Color fundus photograph · captured on a Remidio Fundus on Phone (FOP) camera · image size 1659x2212:
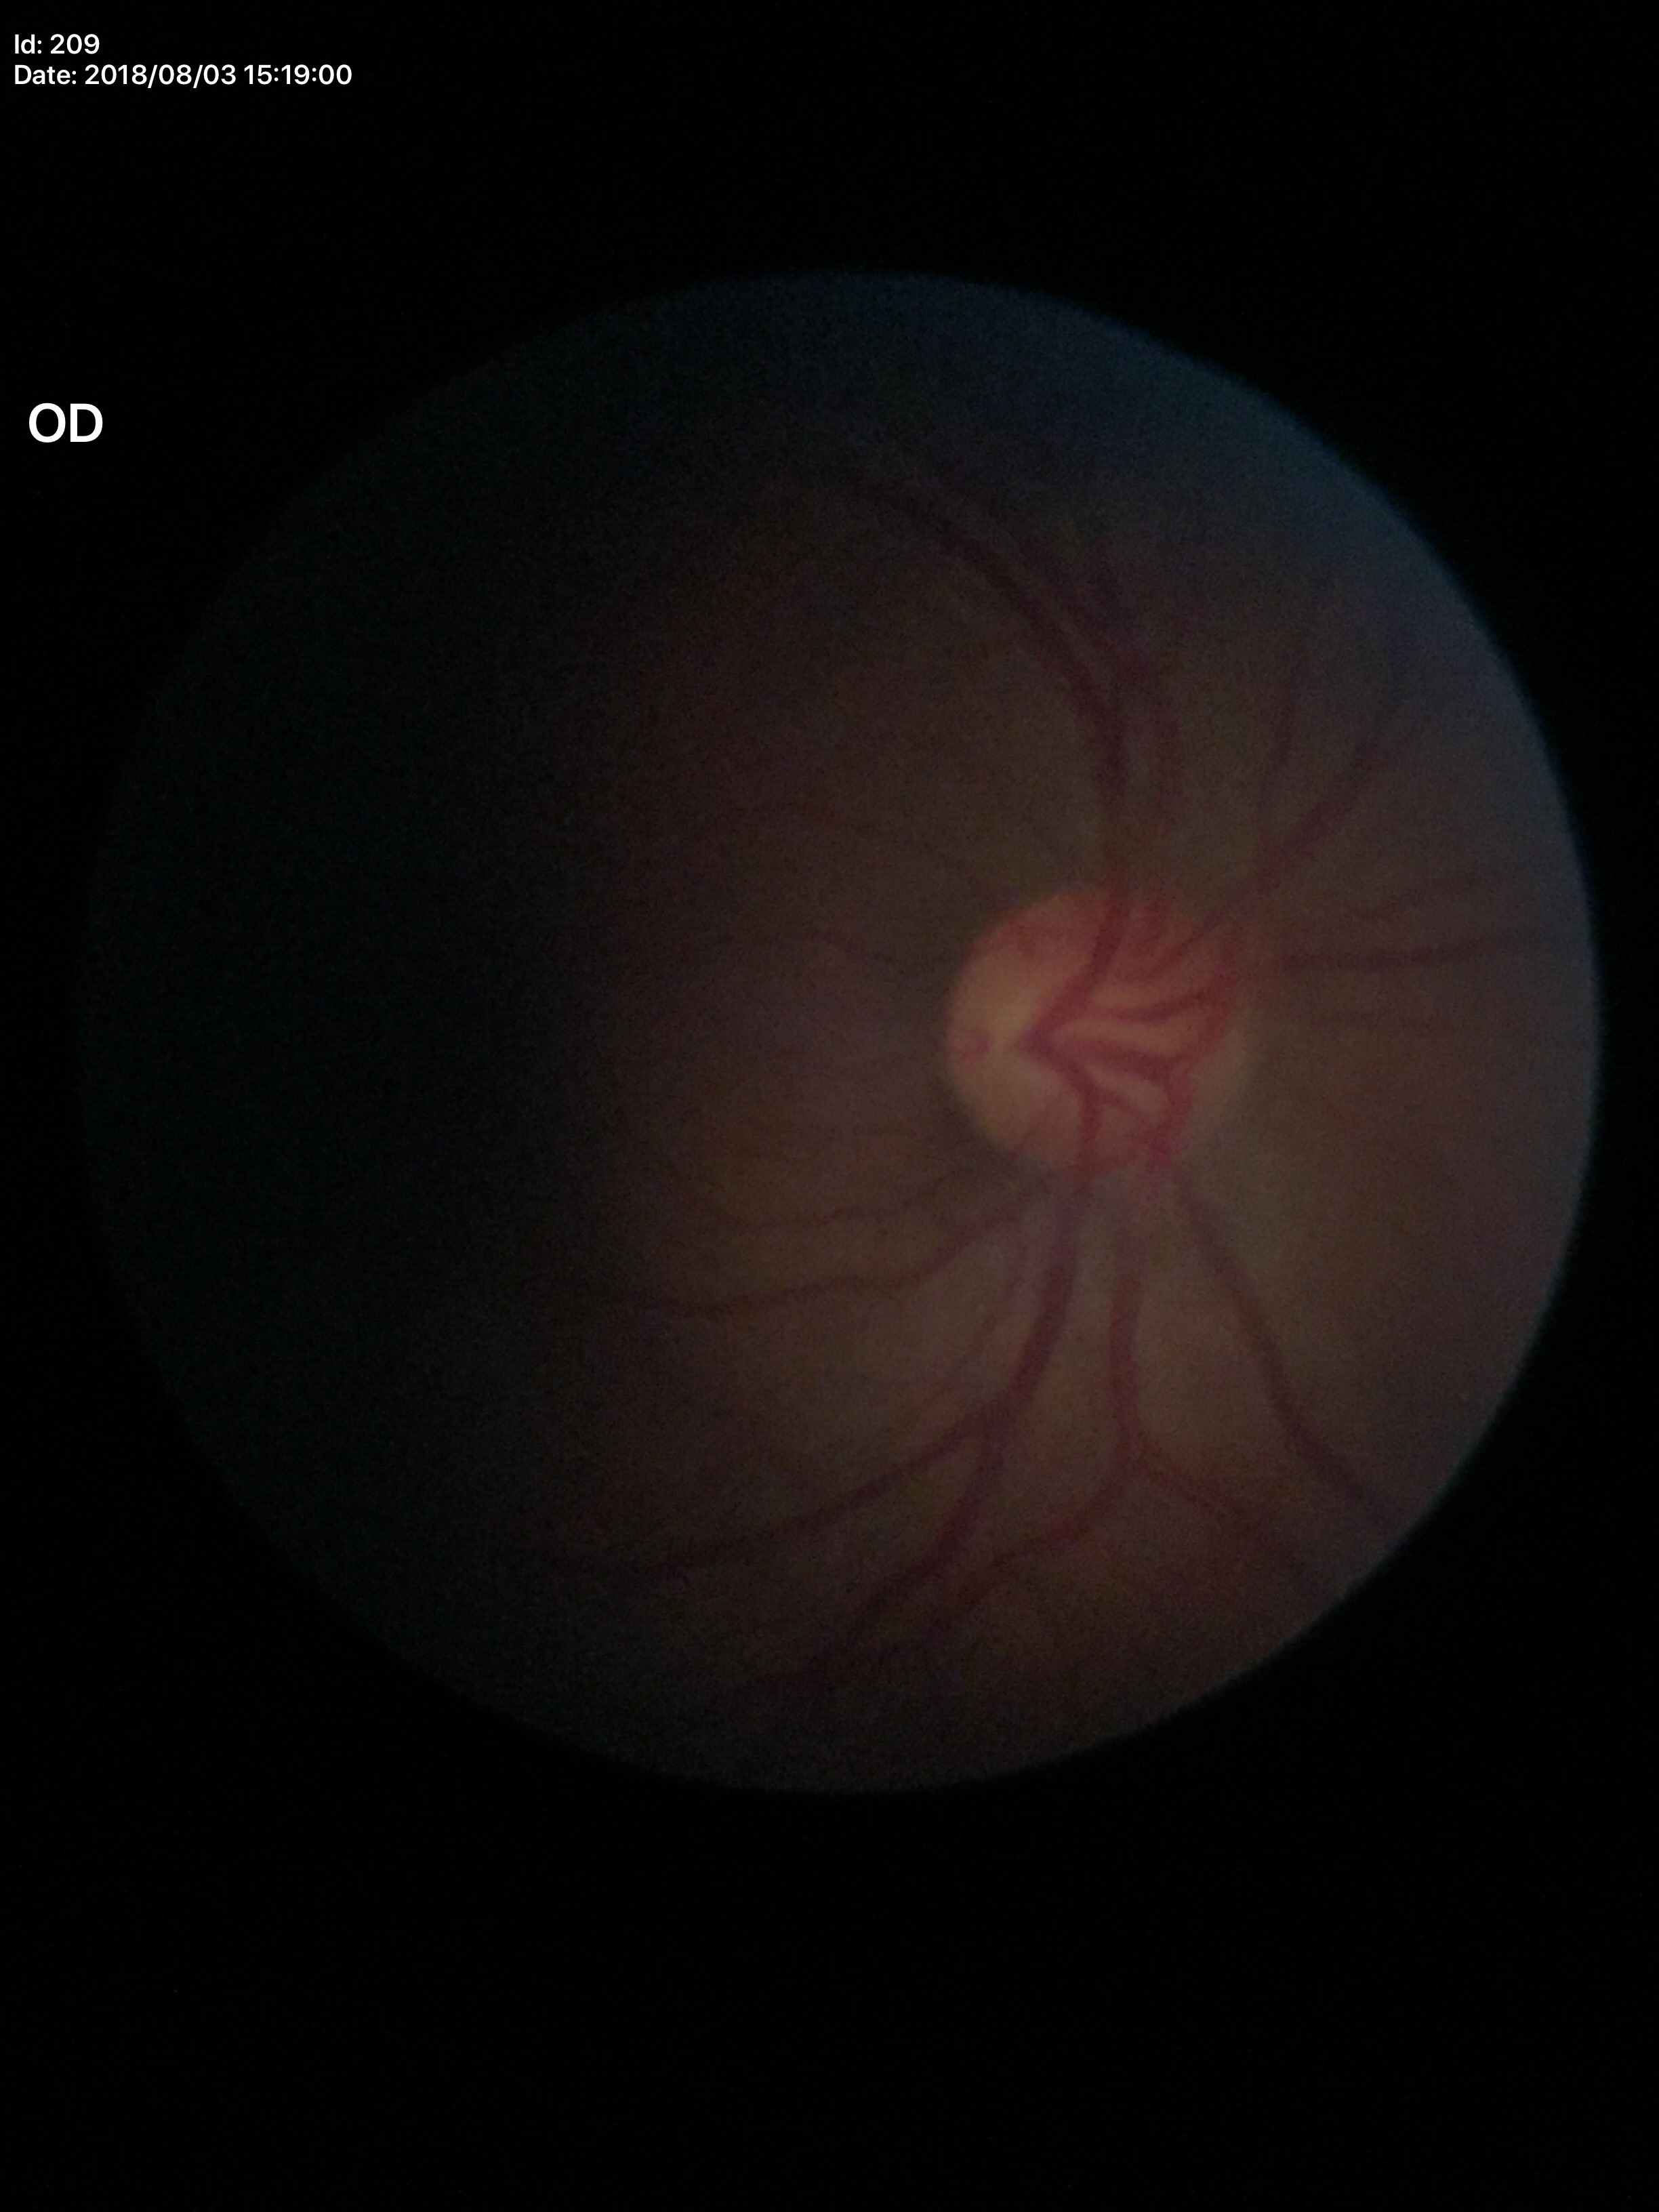

Glaucoma impression: negative (unanimous normal call), area cup-to-disc ratio: 0.24, vertical C/D ratio: 0.49.